Modified Davis grading — 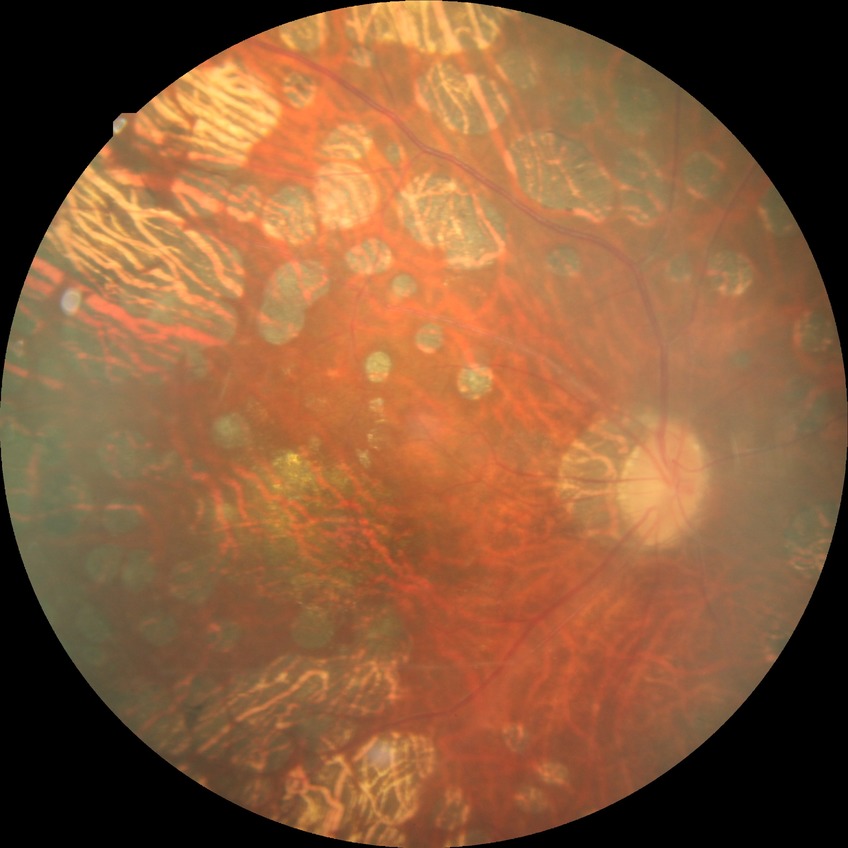

Diabetic retinopathy (DR): PDR (proliferative diabetic retinopathy).